Captured after pupil dilation — 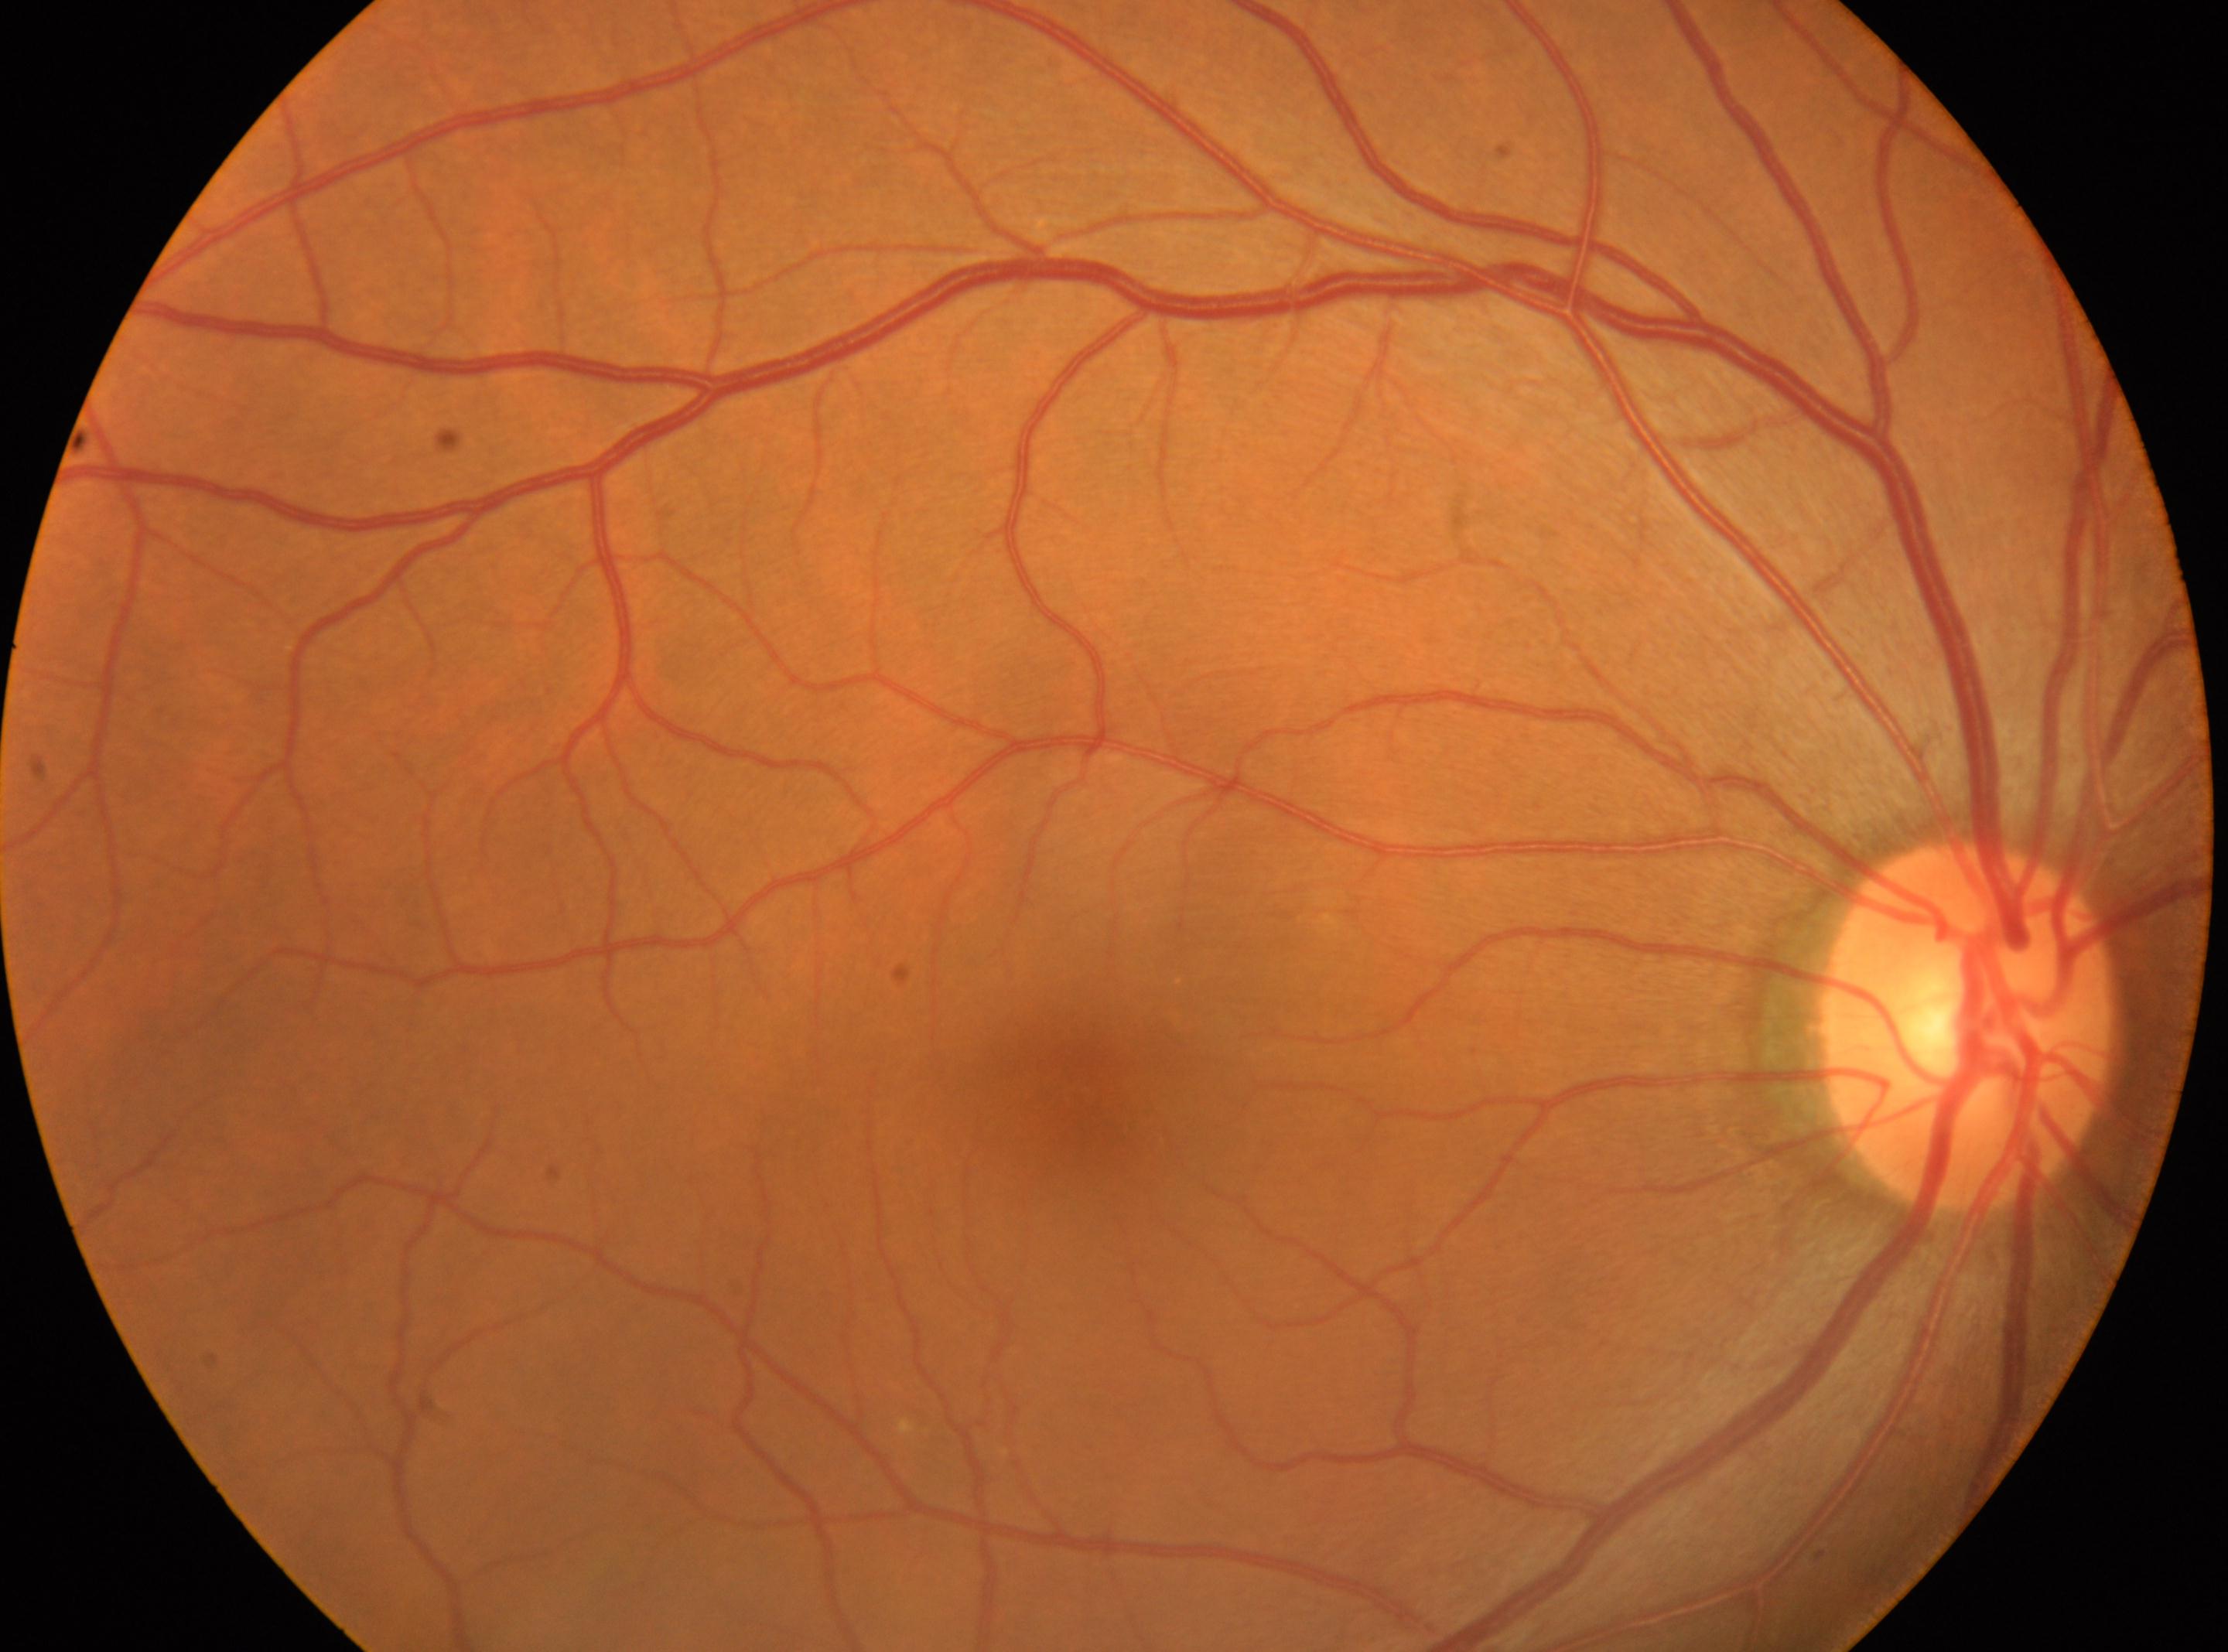

Diabetic retinopathy (DR): no apparent diabetic retinopathy (grade 0). Optic disc located at (x: 1964, y: 1028). This is the right eye. Macular center located at (x: 1077, y: 1089). No signs of diabetic retinopathy.